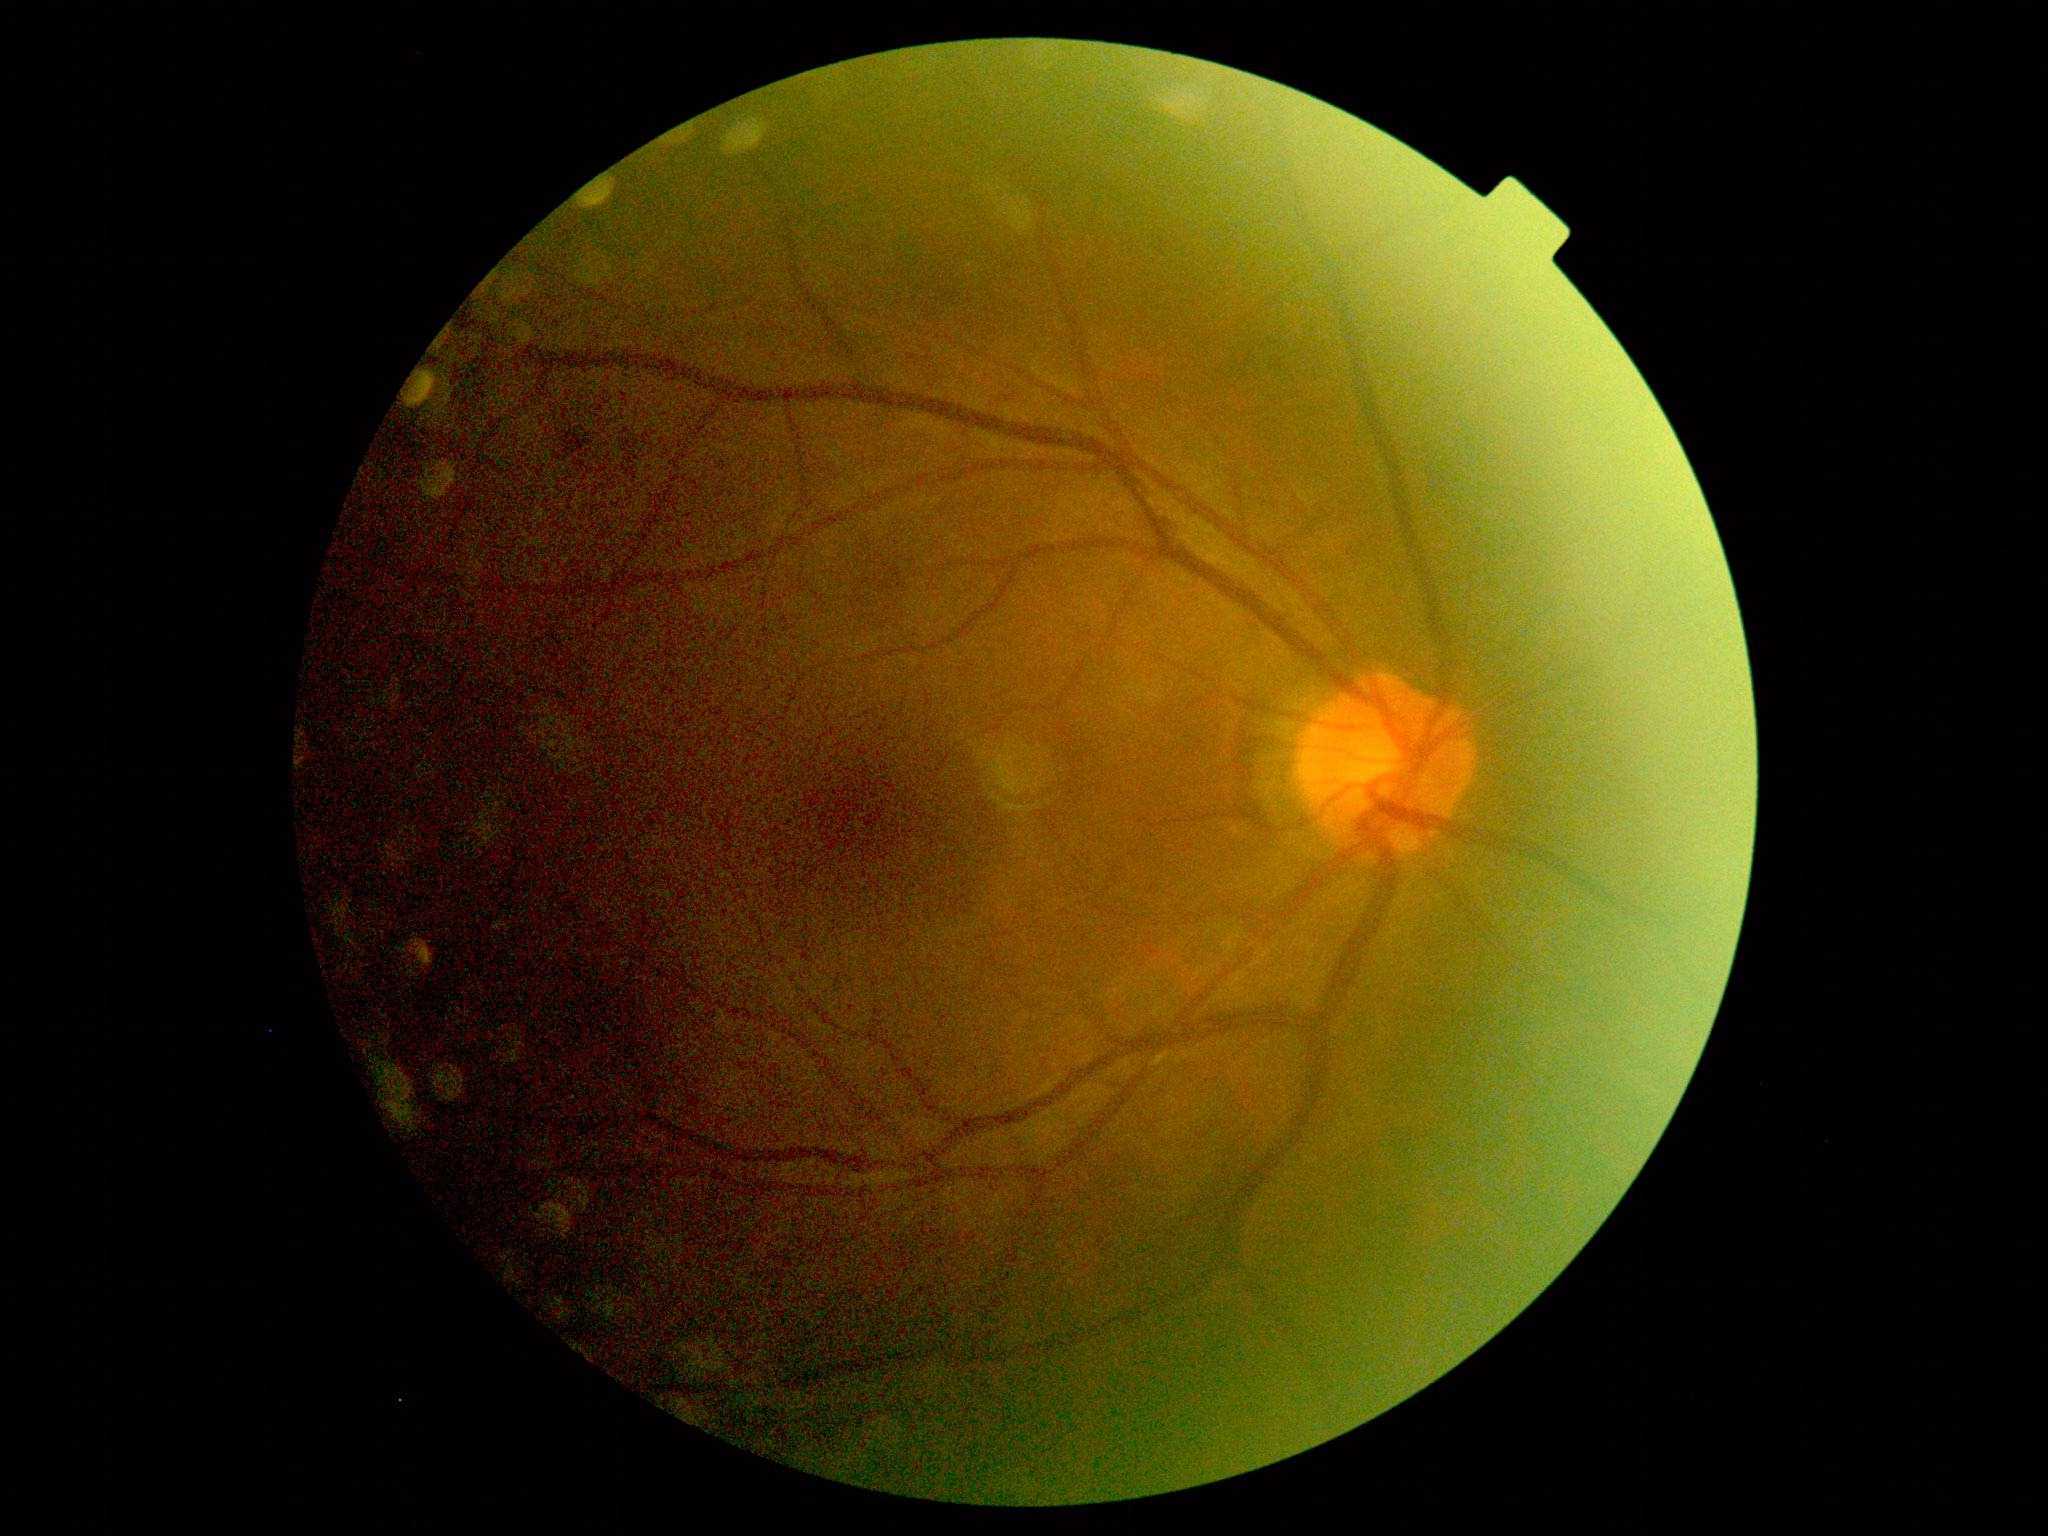
DR grade: 2.